UWF retinal mosaic.
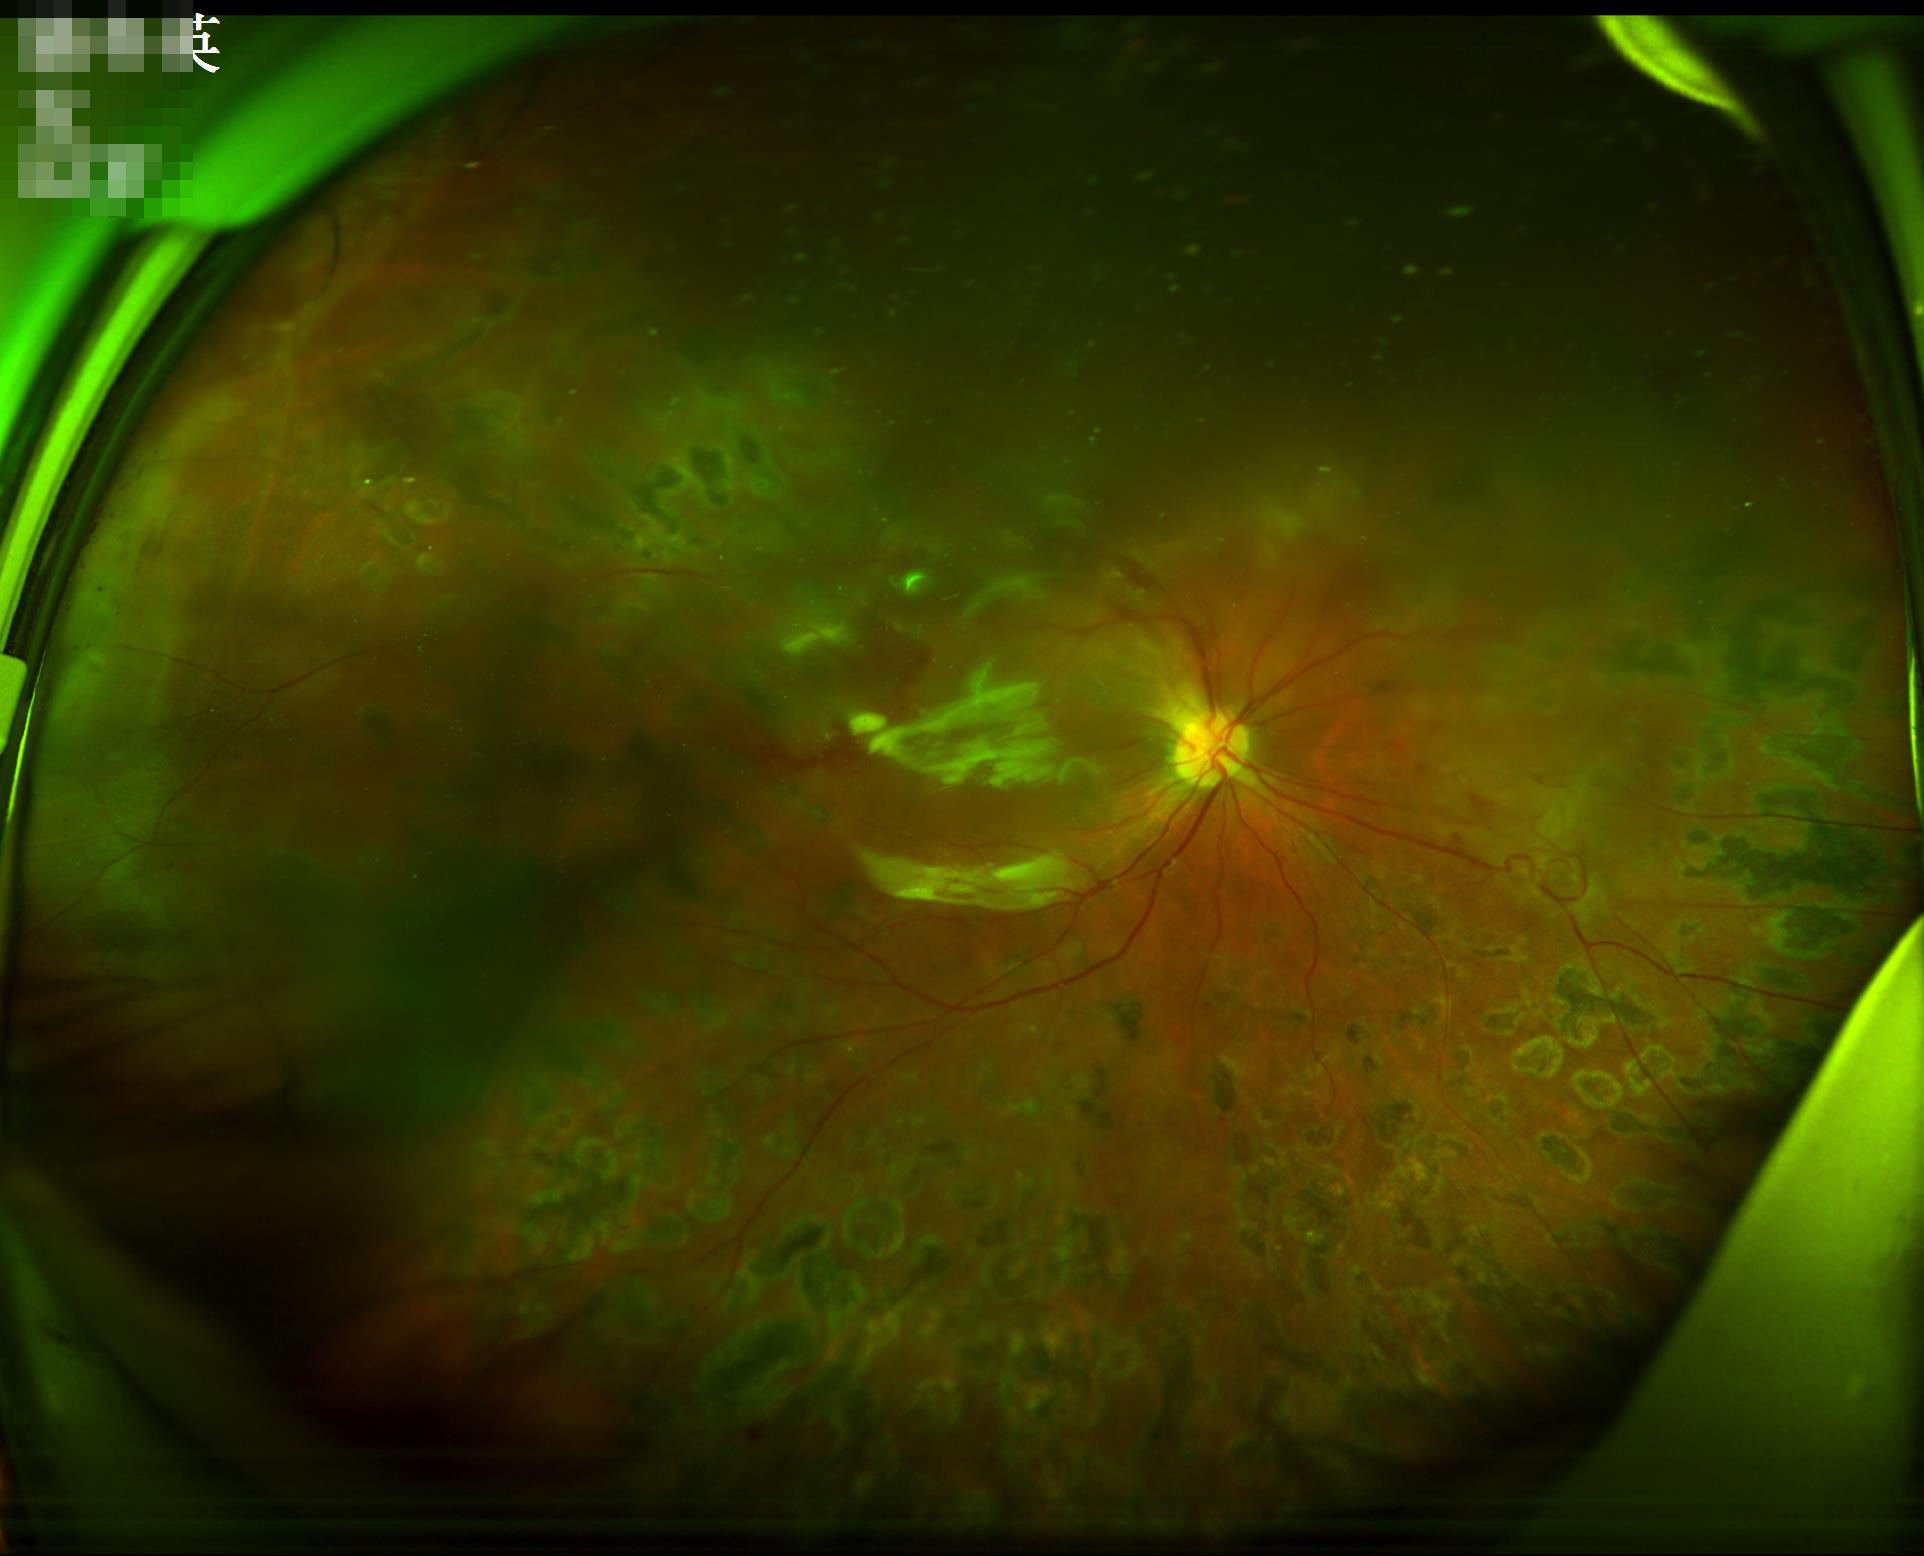
Image quality is inadequate for diagnostic use.
There is over- or under-exposure or a color cast.
The image is blurry.